848 x 848 pixels · NIDEK AFC-230: 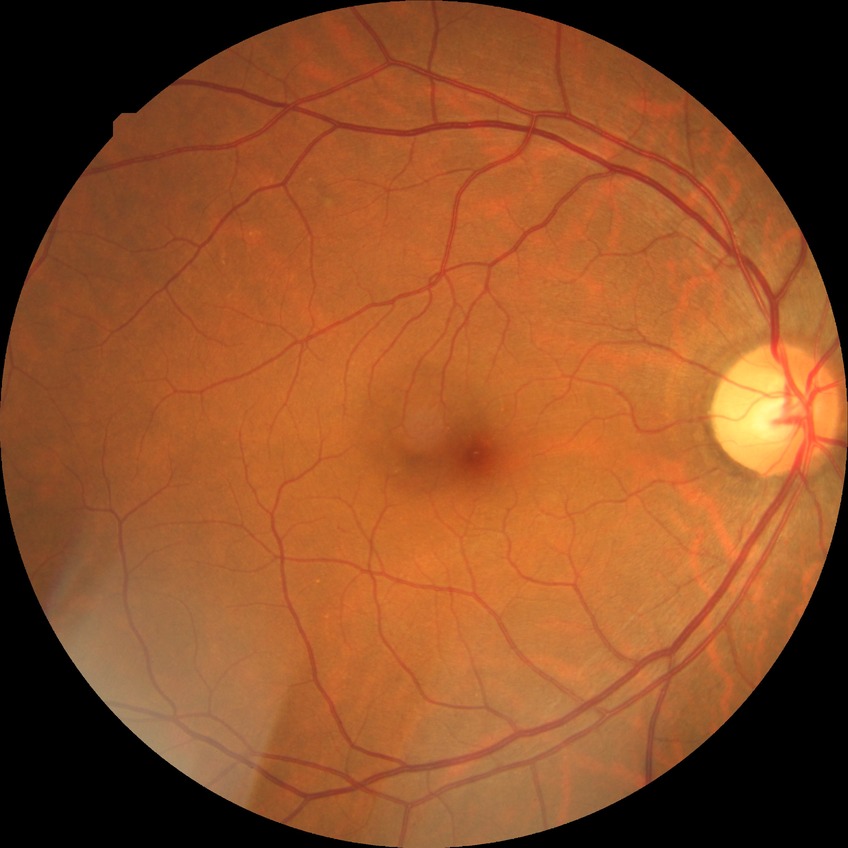

Diabetic retinopathy (DR): NDR (no diabetic retinopathy).